Retinal fundus photograph · image size 240x240 — 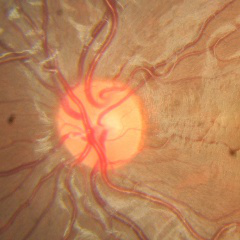 The image shows no signs of glaucoma.